45 degree fundus photograph. No pharmacologic dilation.
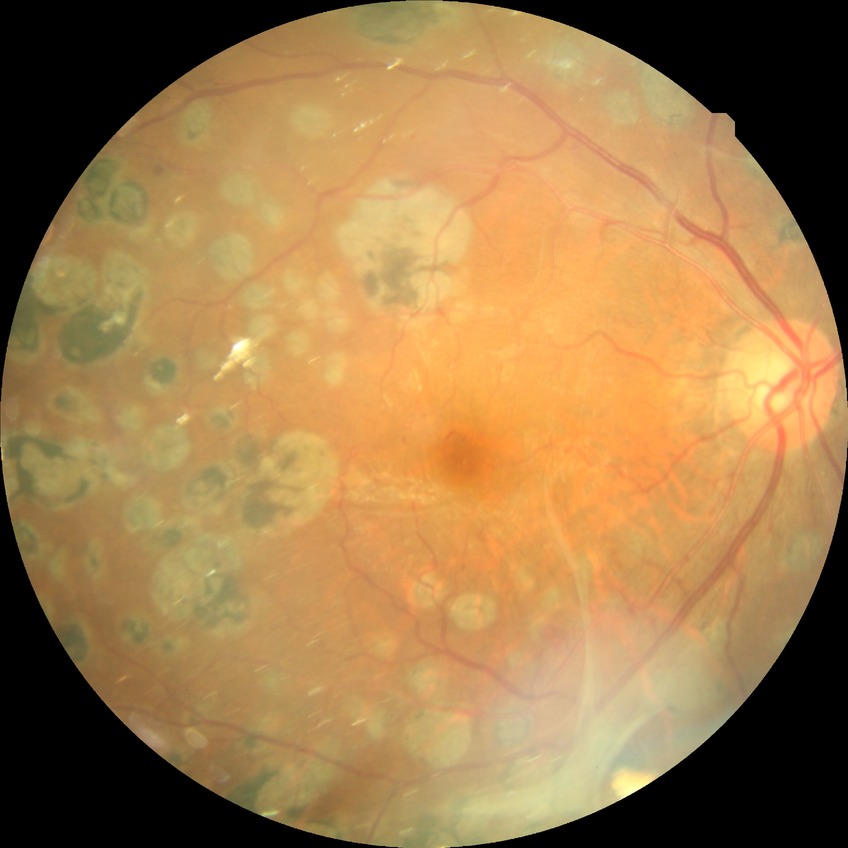

DR severity is PDR.